Acquired with a NIDEK AFC-230, no pharmacologic dilation, 45° FOV:
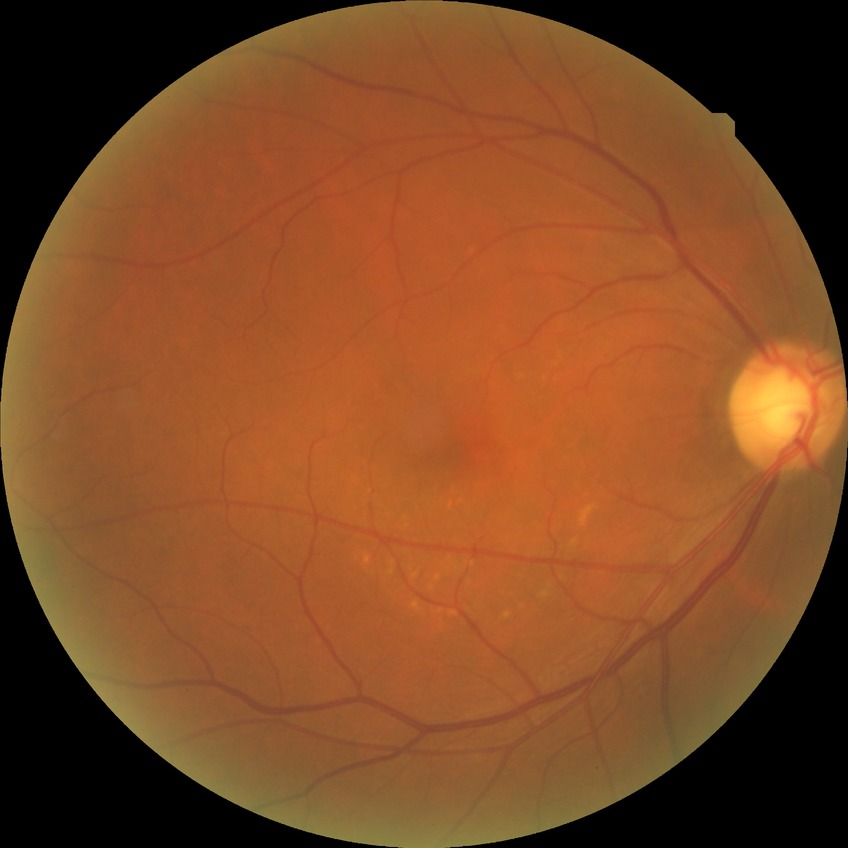 Davis grading@no diabetic retinopathy.